848 by 848 pixels.
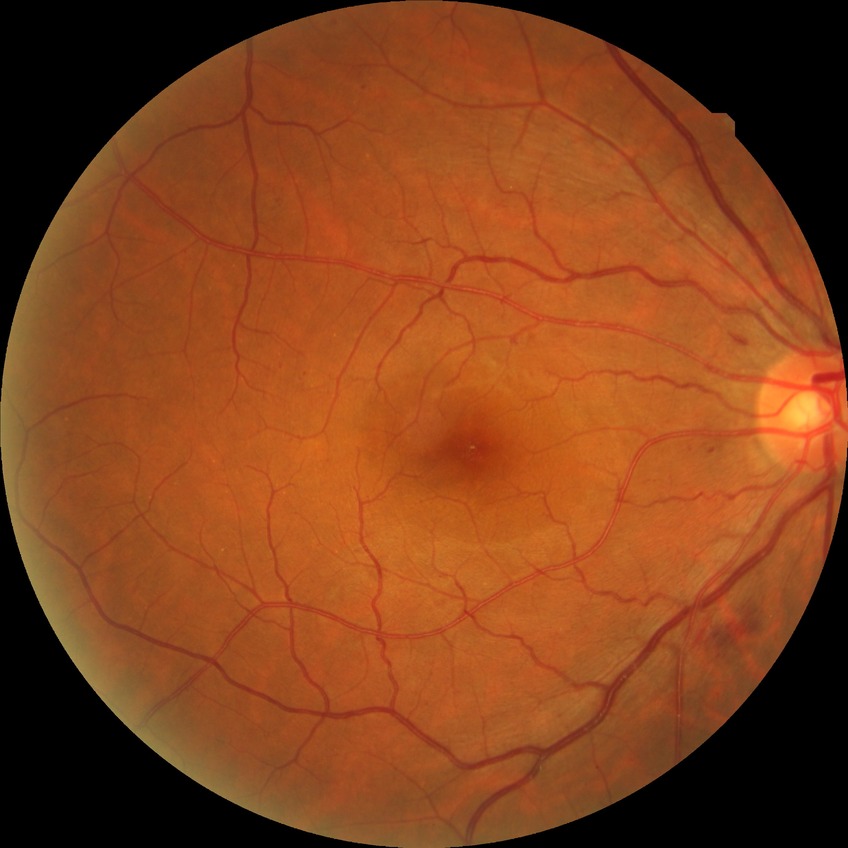
Diabetic retinopathy grade is simple diabetic retinopathy.